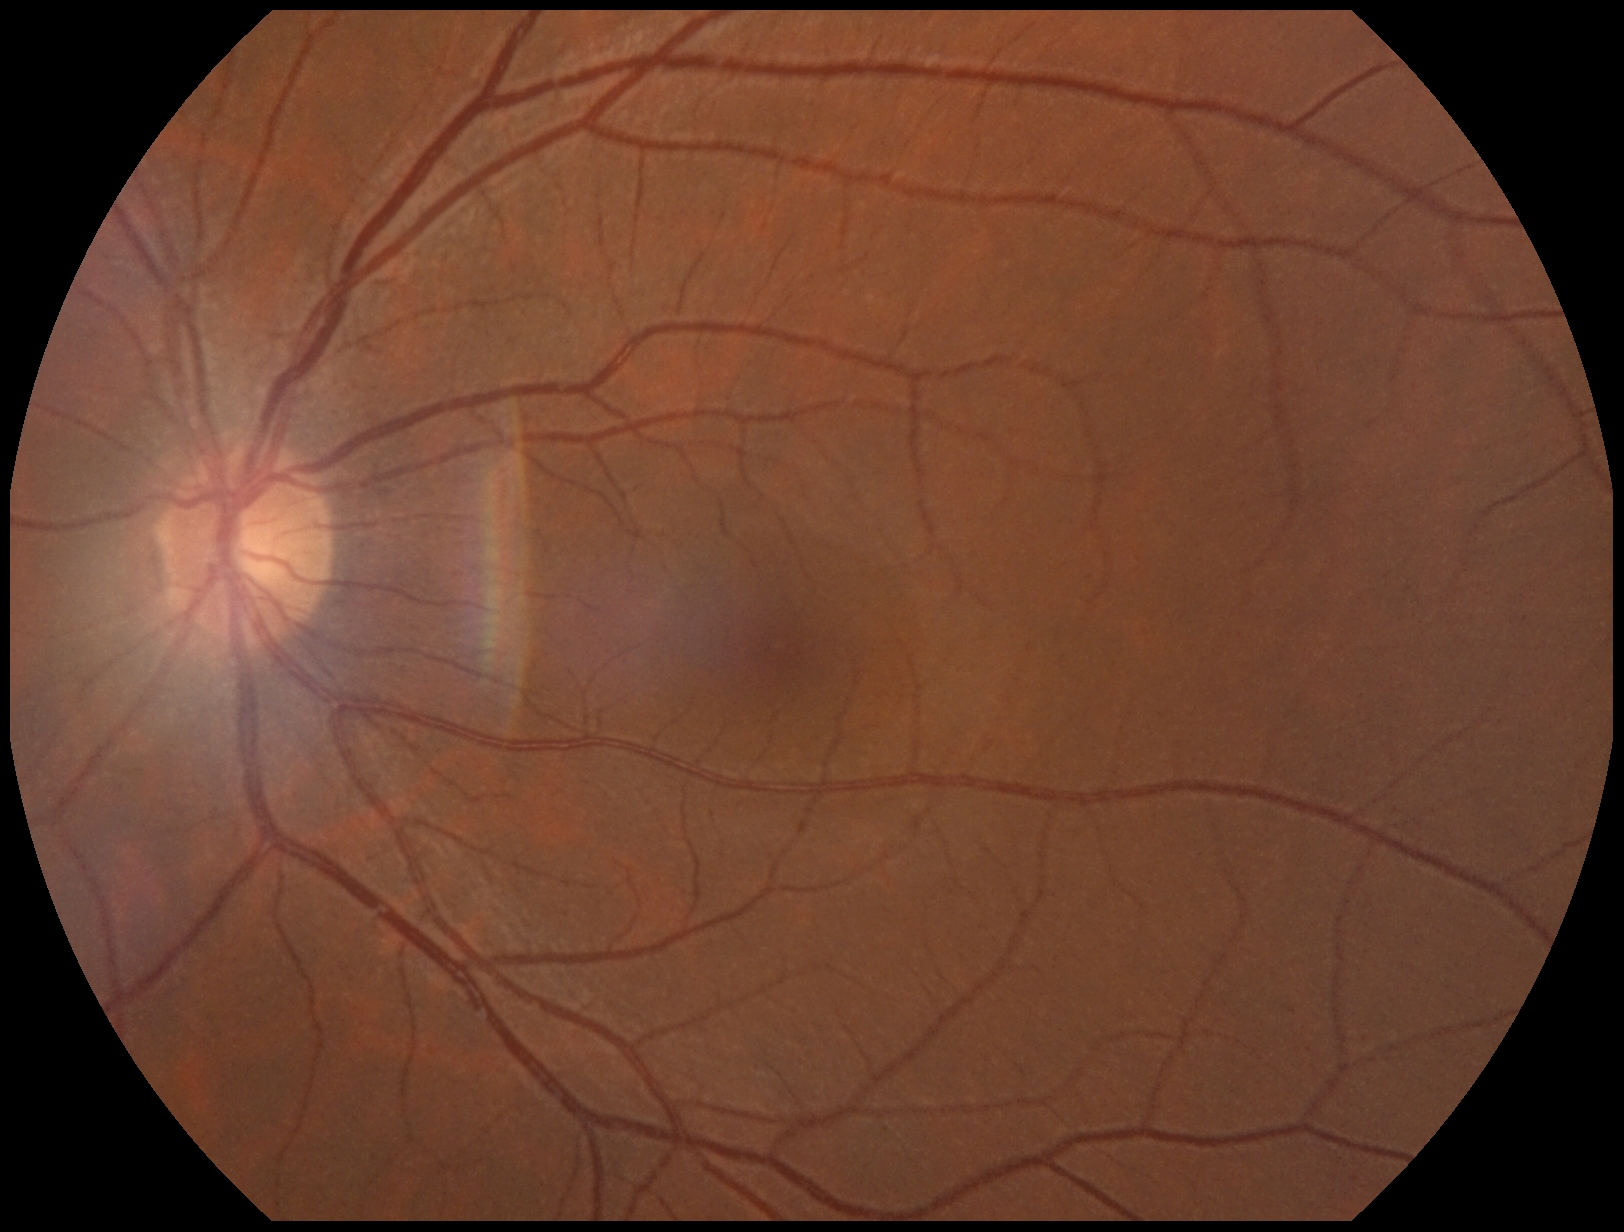
Findings:
– diabetic retinopathy (DR) — 0